45 degree fundus photograph; 848x848px:
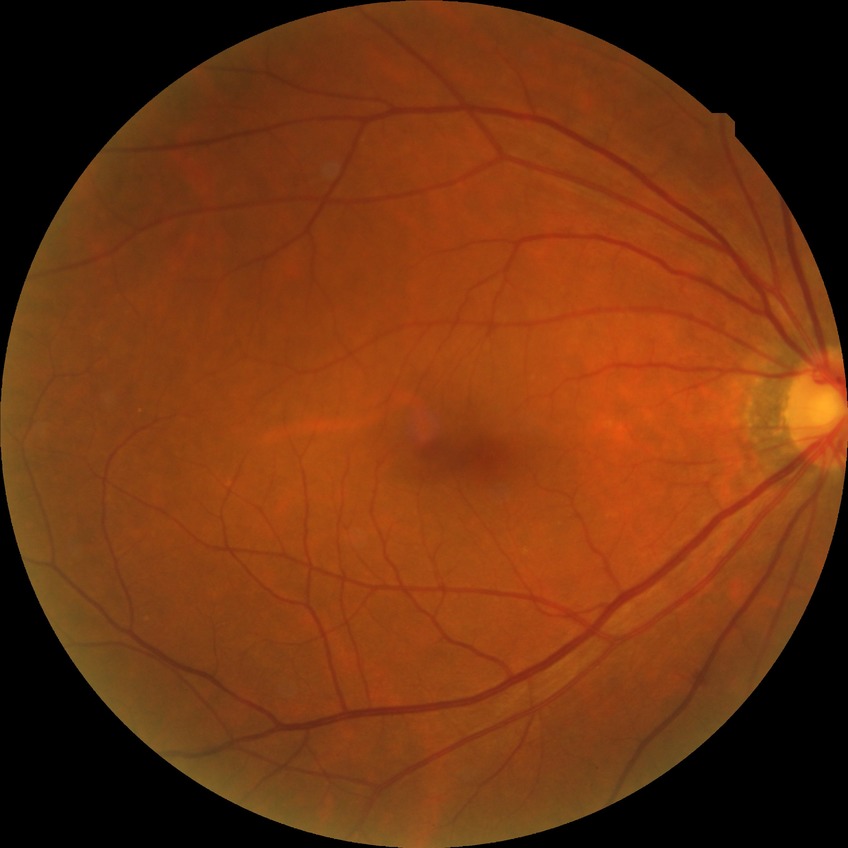 Diabetic retinopathy (DR): SDR (simple diabetic retinopathy).